CFP, 45° field of view, 2352x1568px:
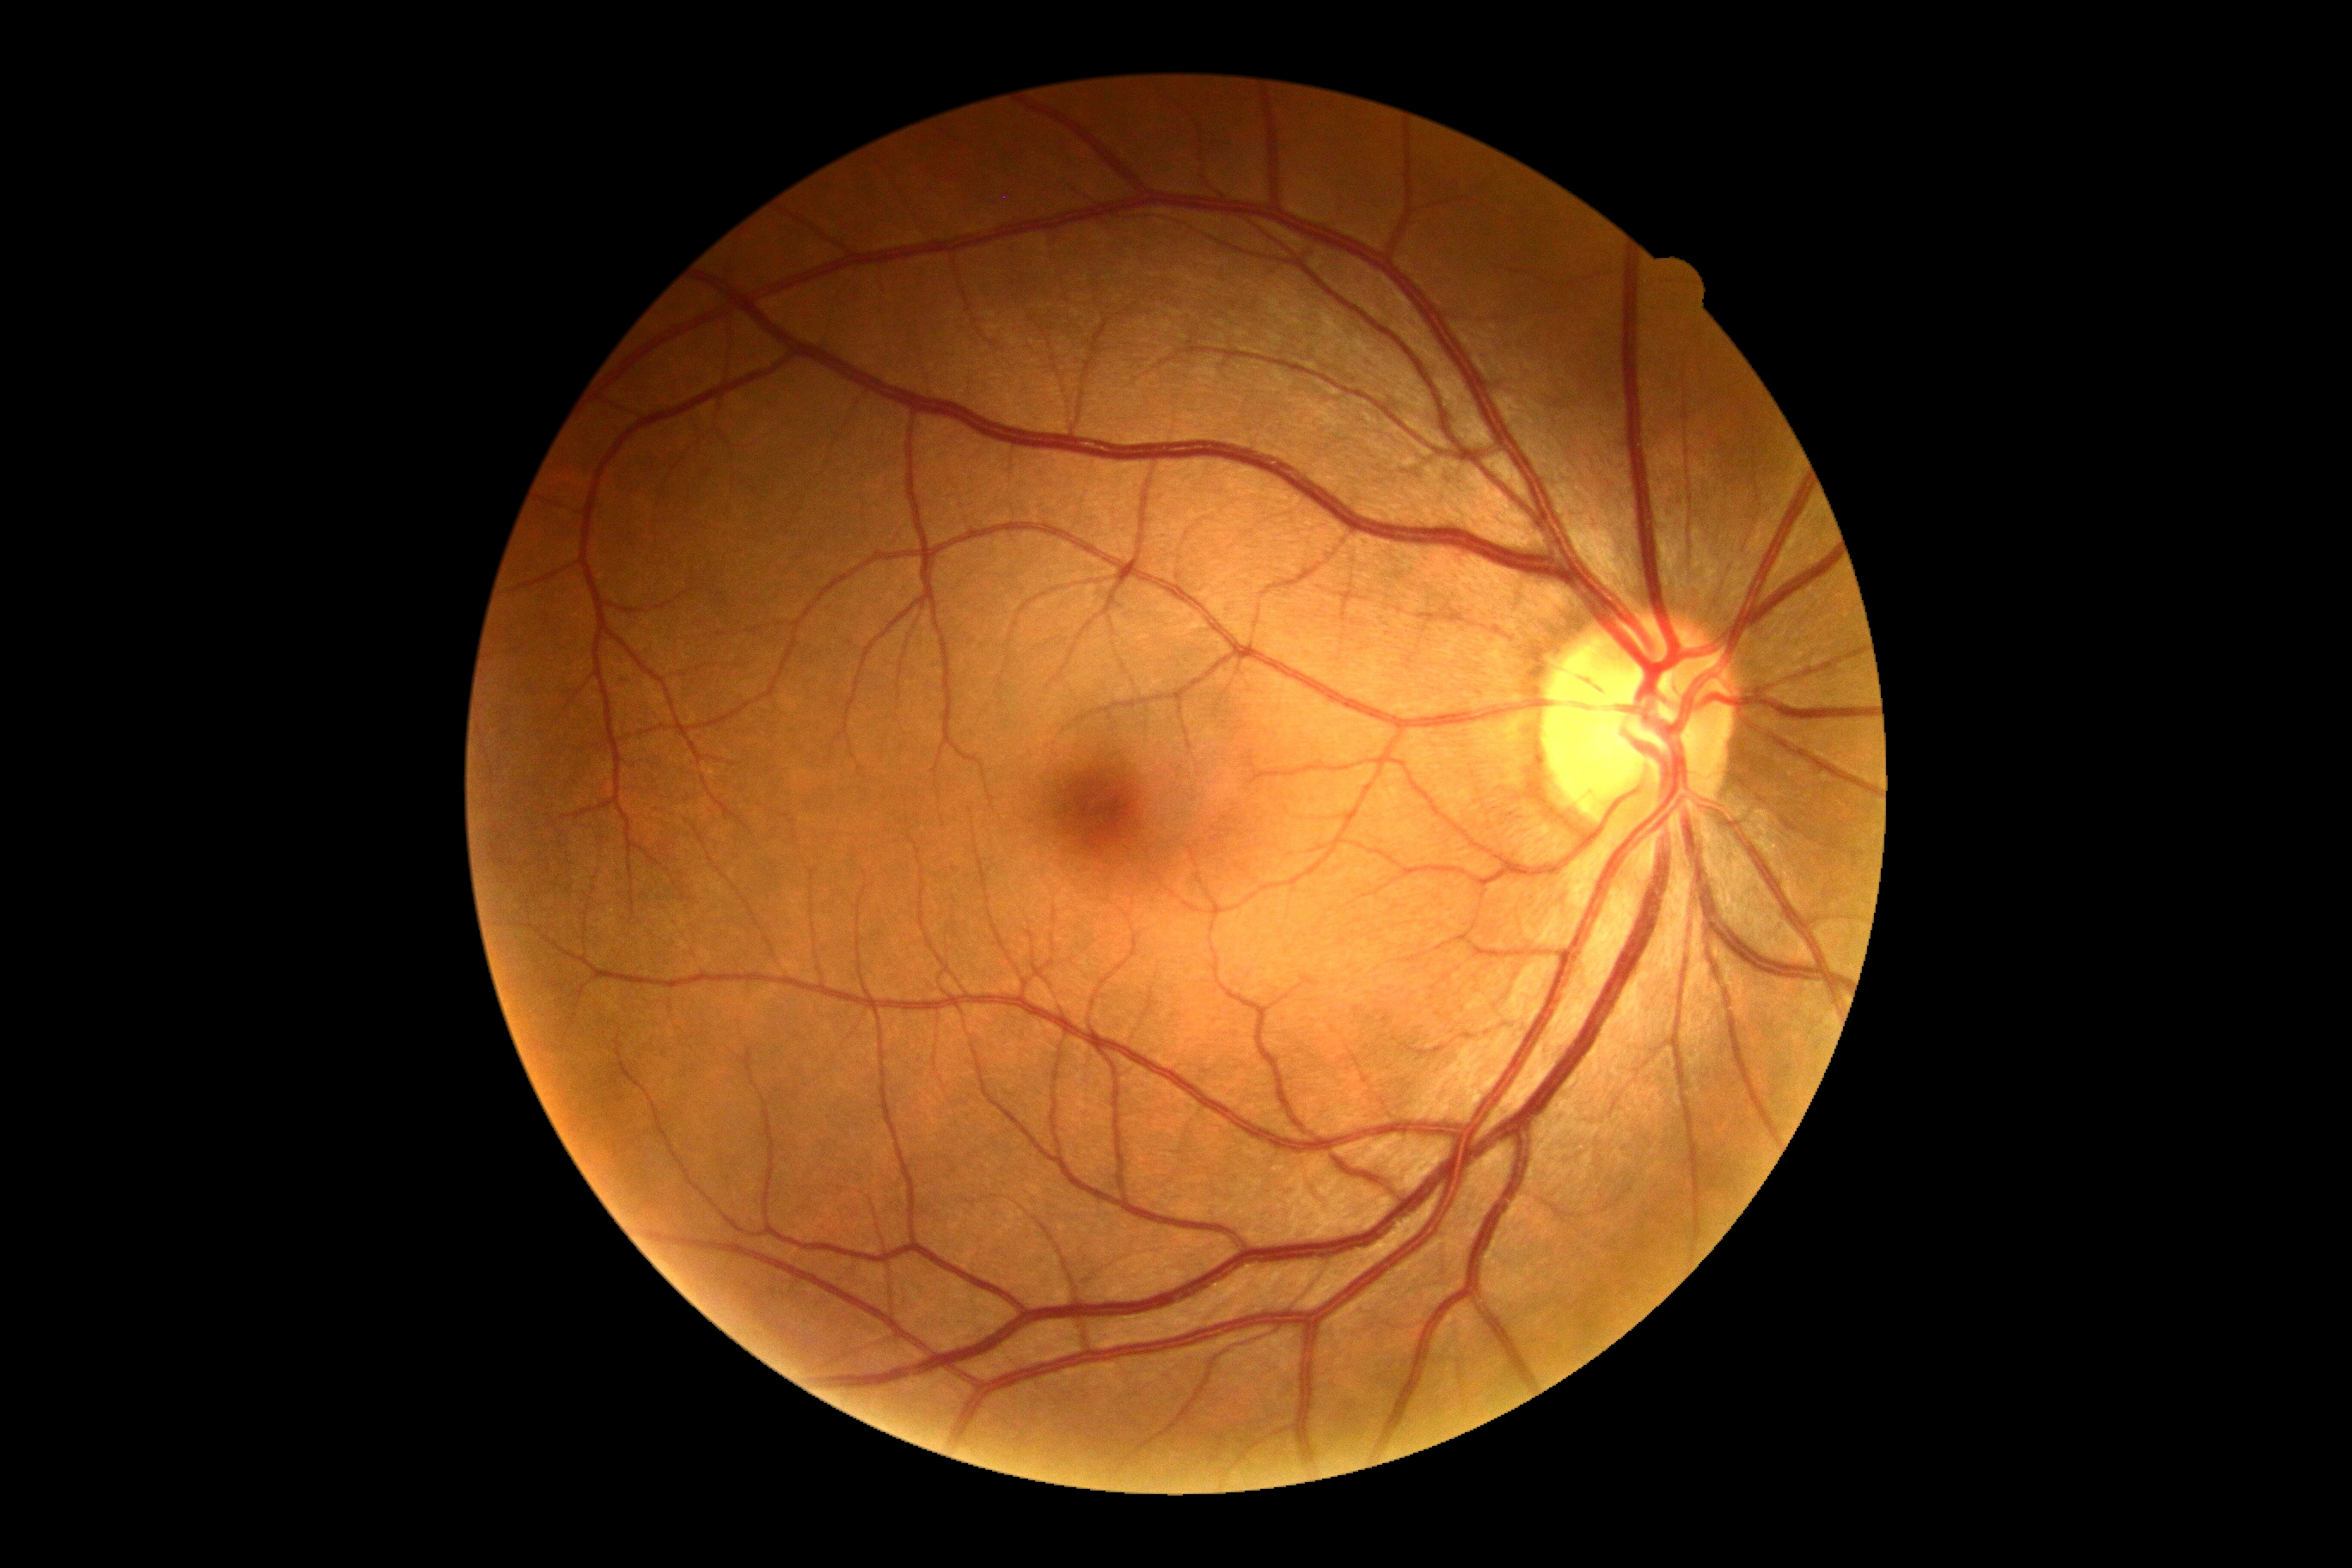

DR is no apparent retinopathy (grade 0) — no visible signs of diabetic retinopathy. No DR findings.